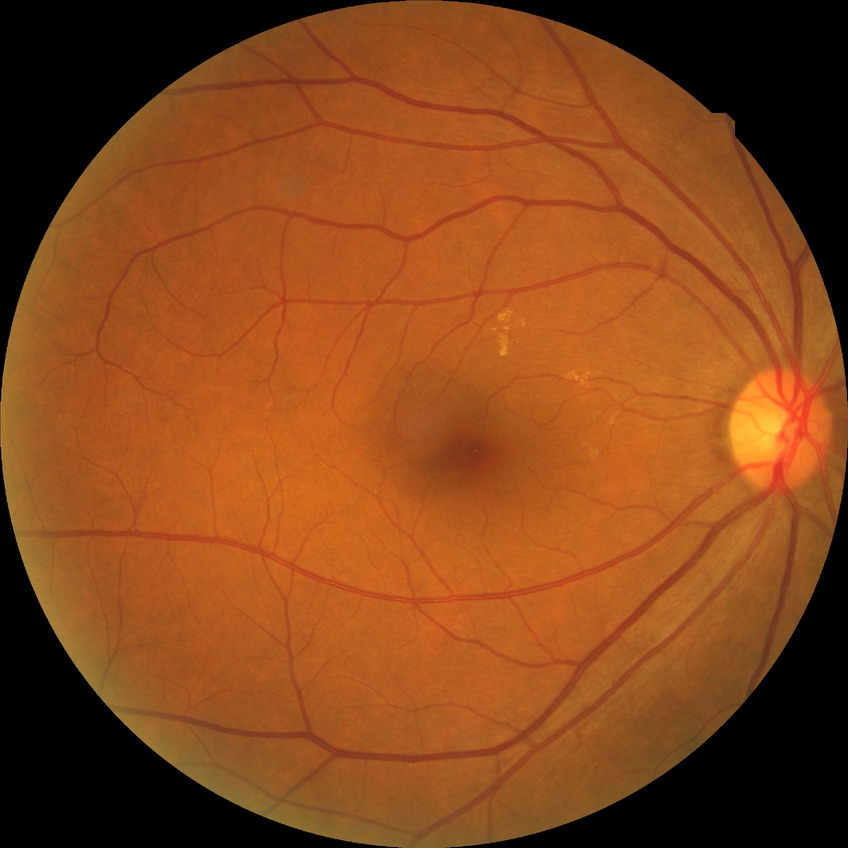 Annotations:
– diabetic retinopathy stage — no diabetic retinopathy